Phoenix ICON, 100° FOV; wide-field fundus photograph of an infant; 1240x1240: 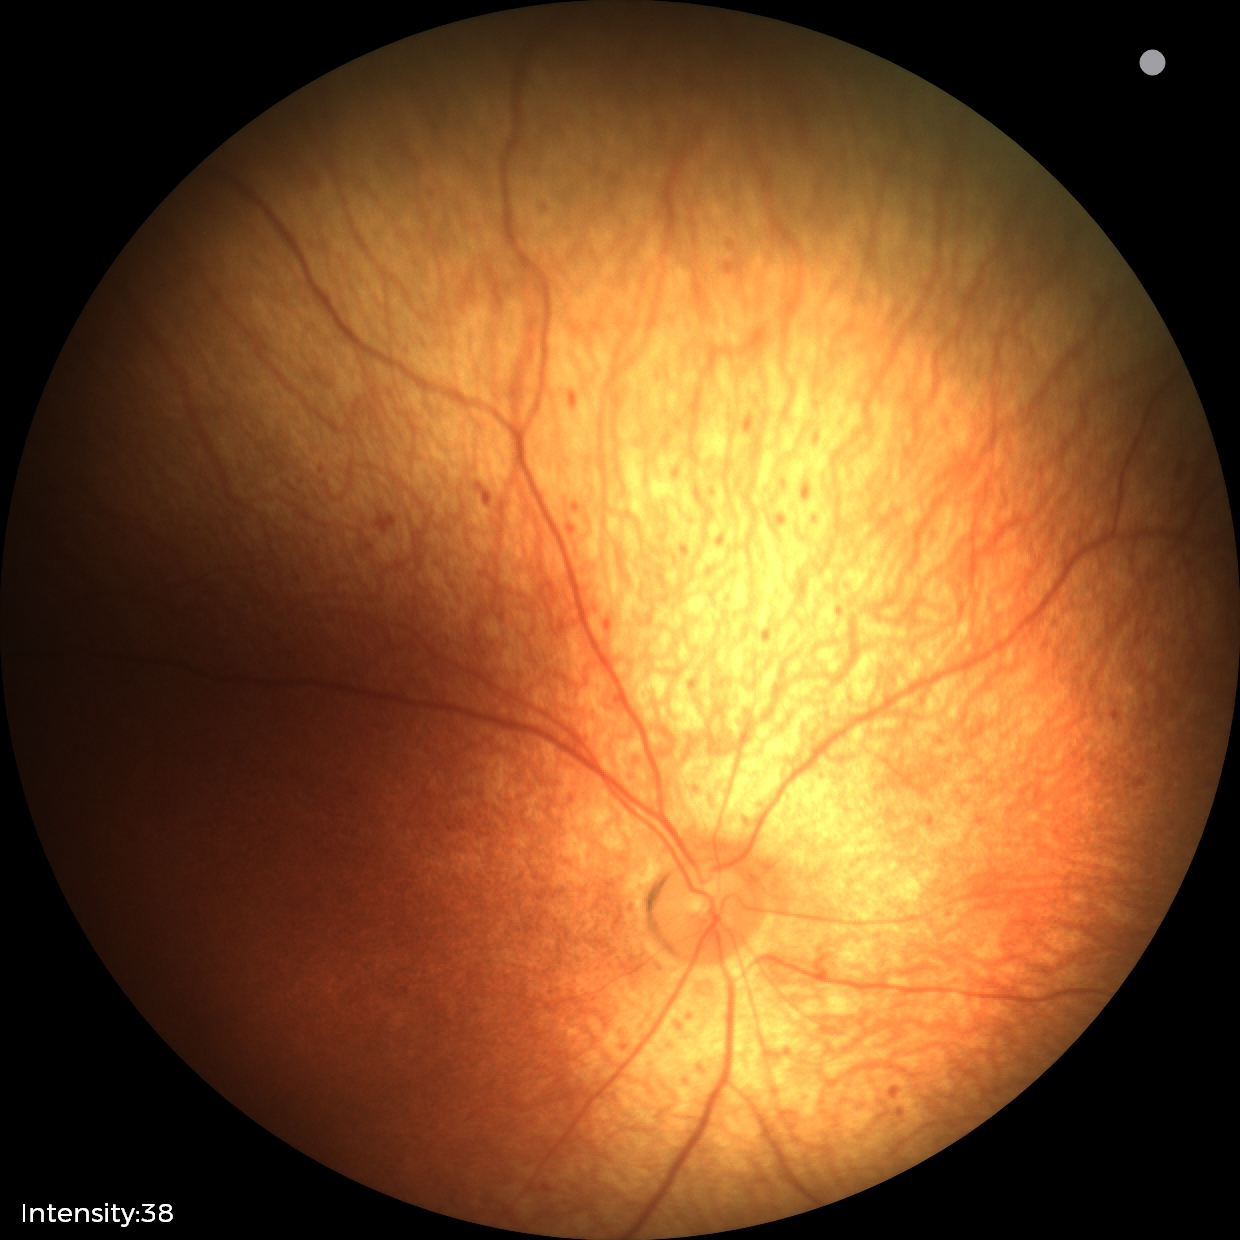

Screening diagnosis: status post retinopathy of prematurity (ROP).